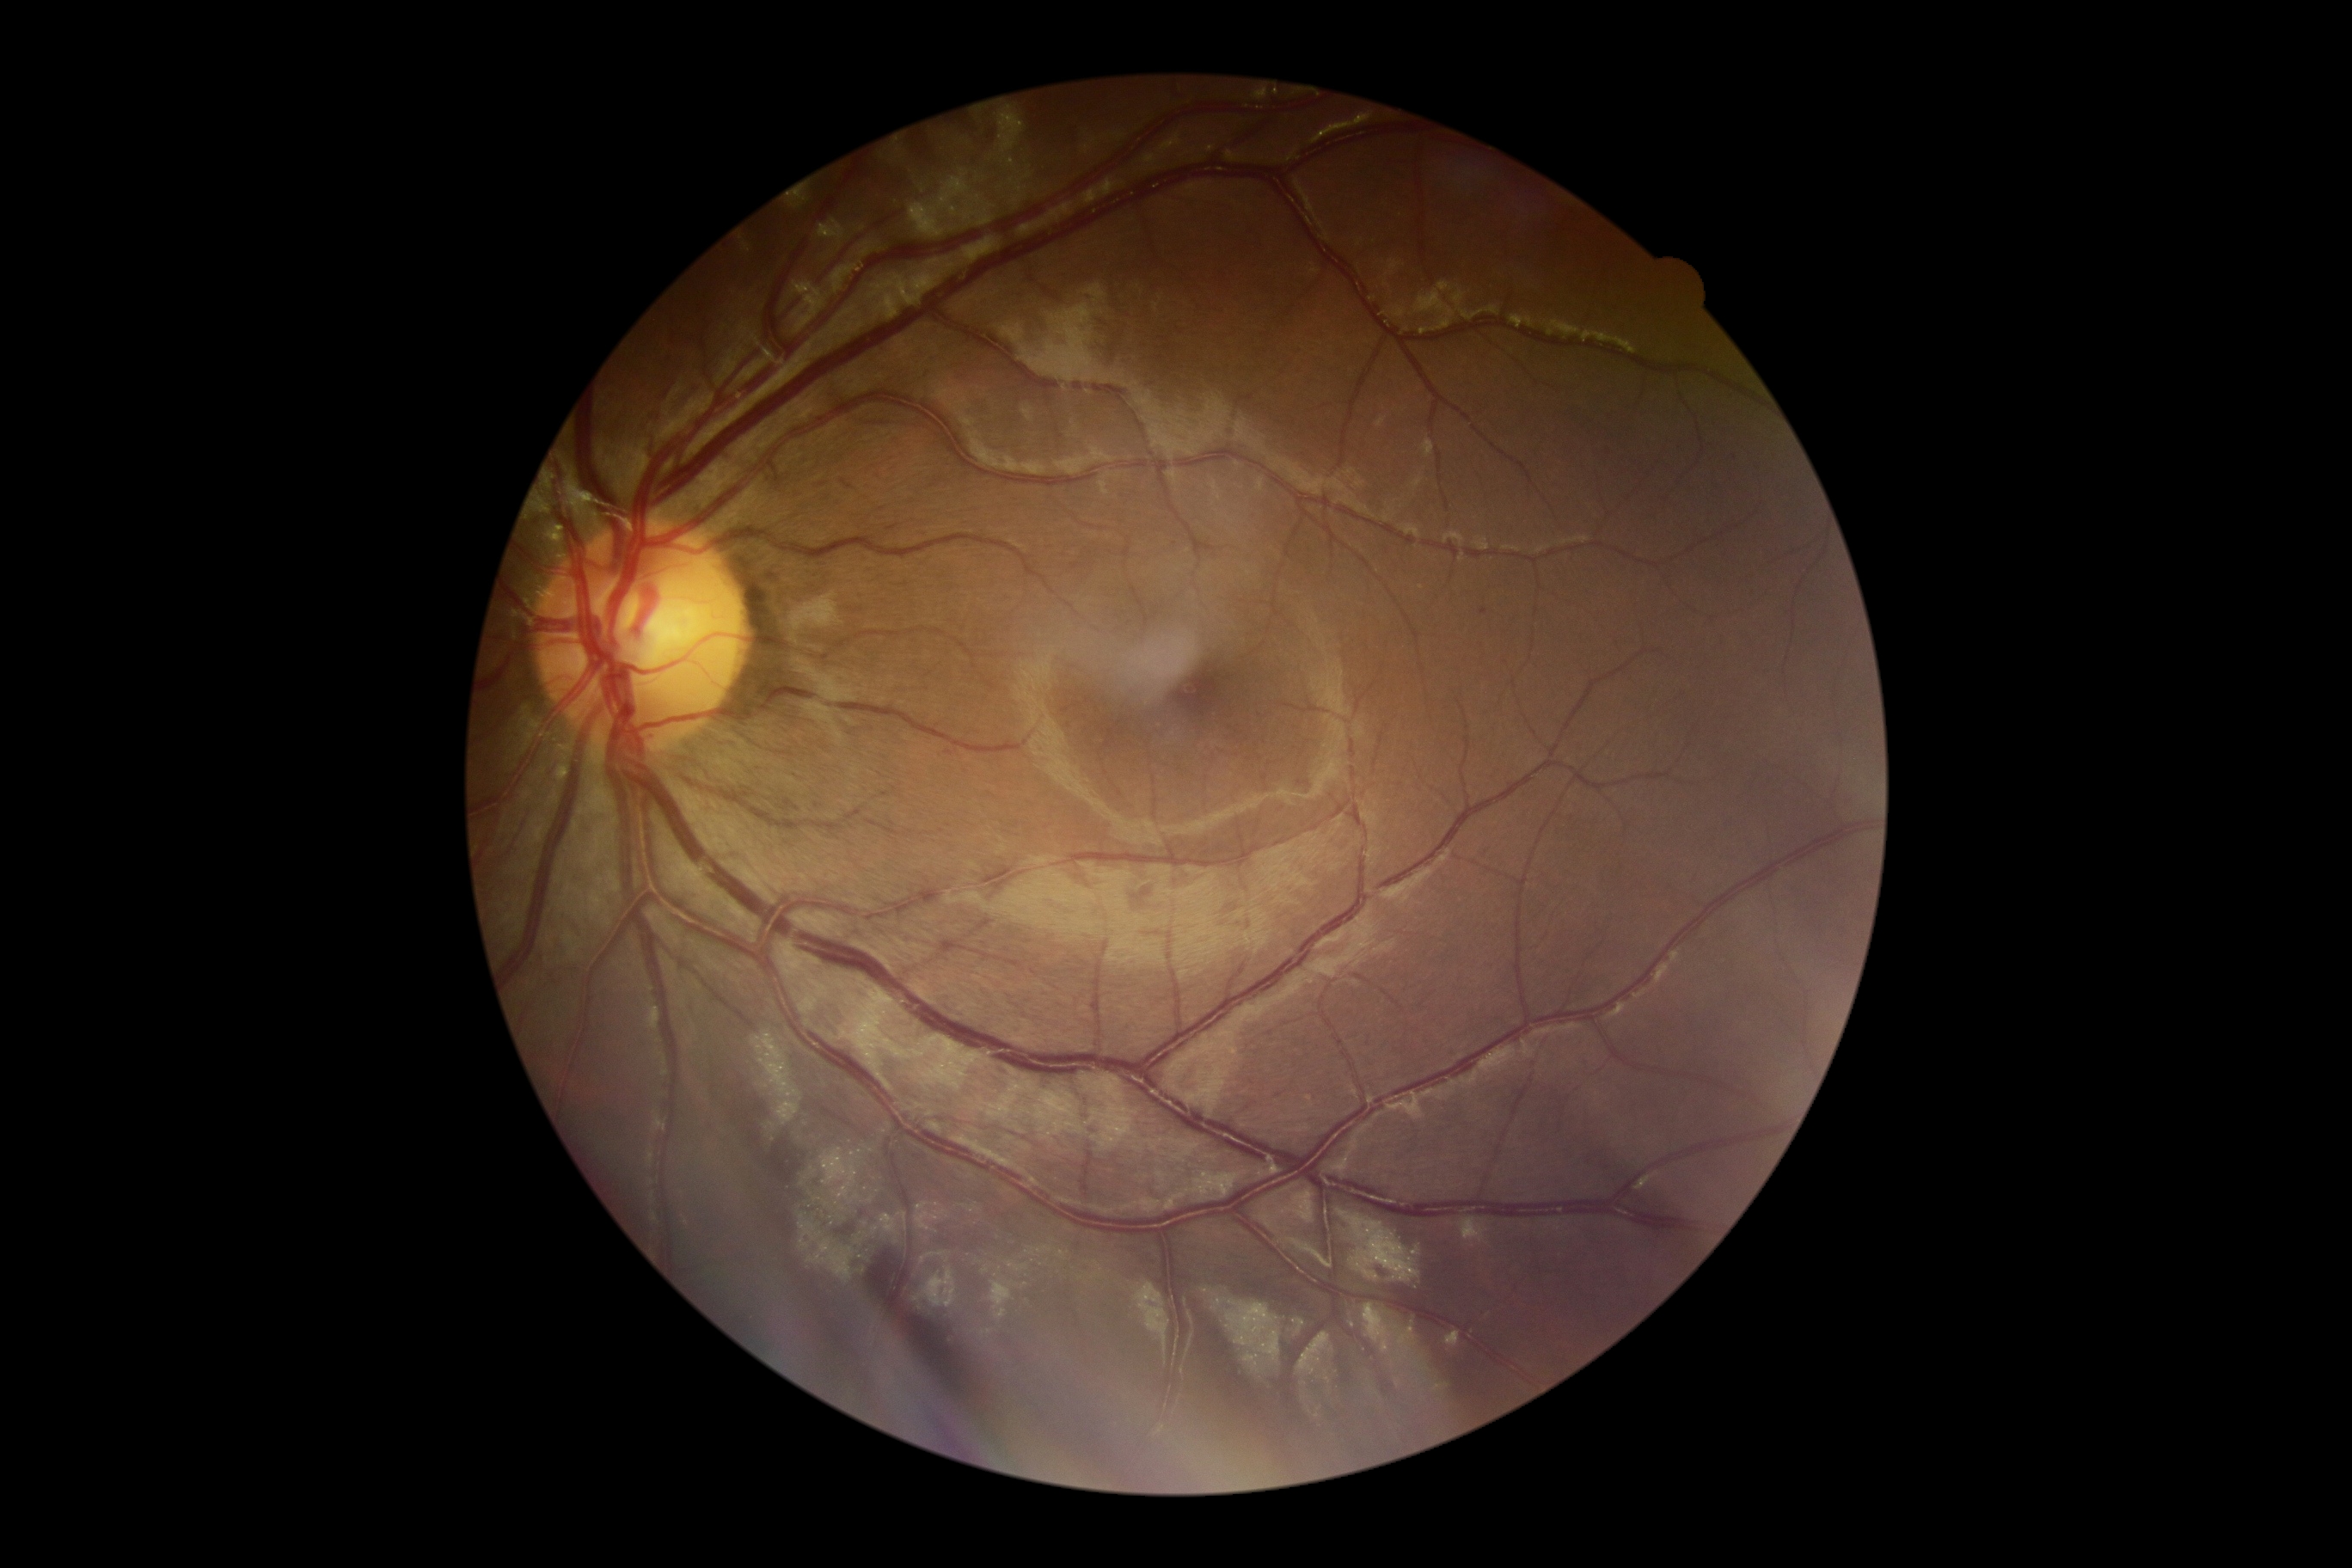 - retinopathy grade: 1